200° FOV · UWF retinal mosaic
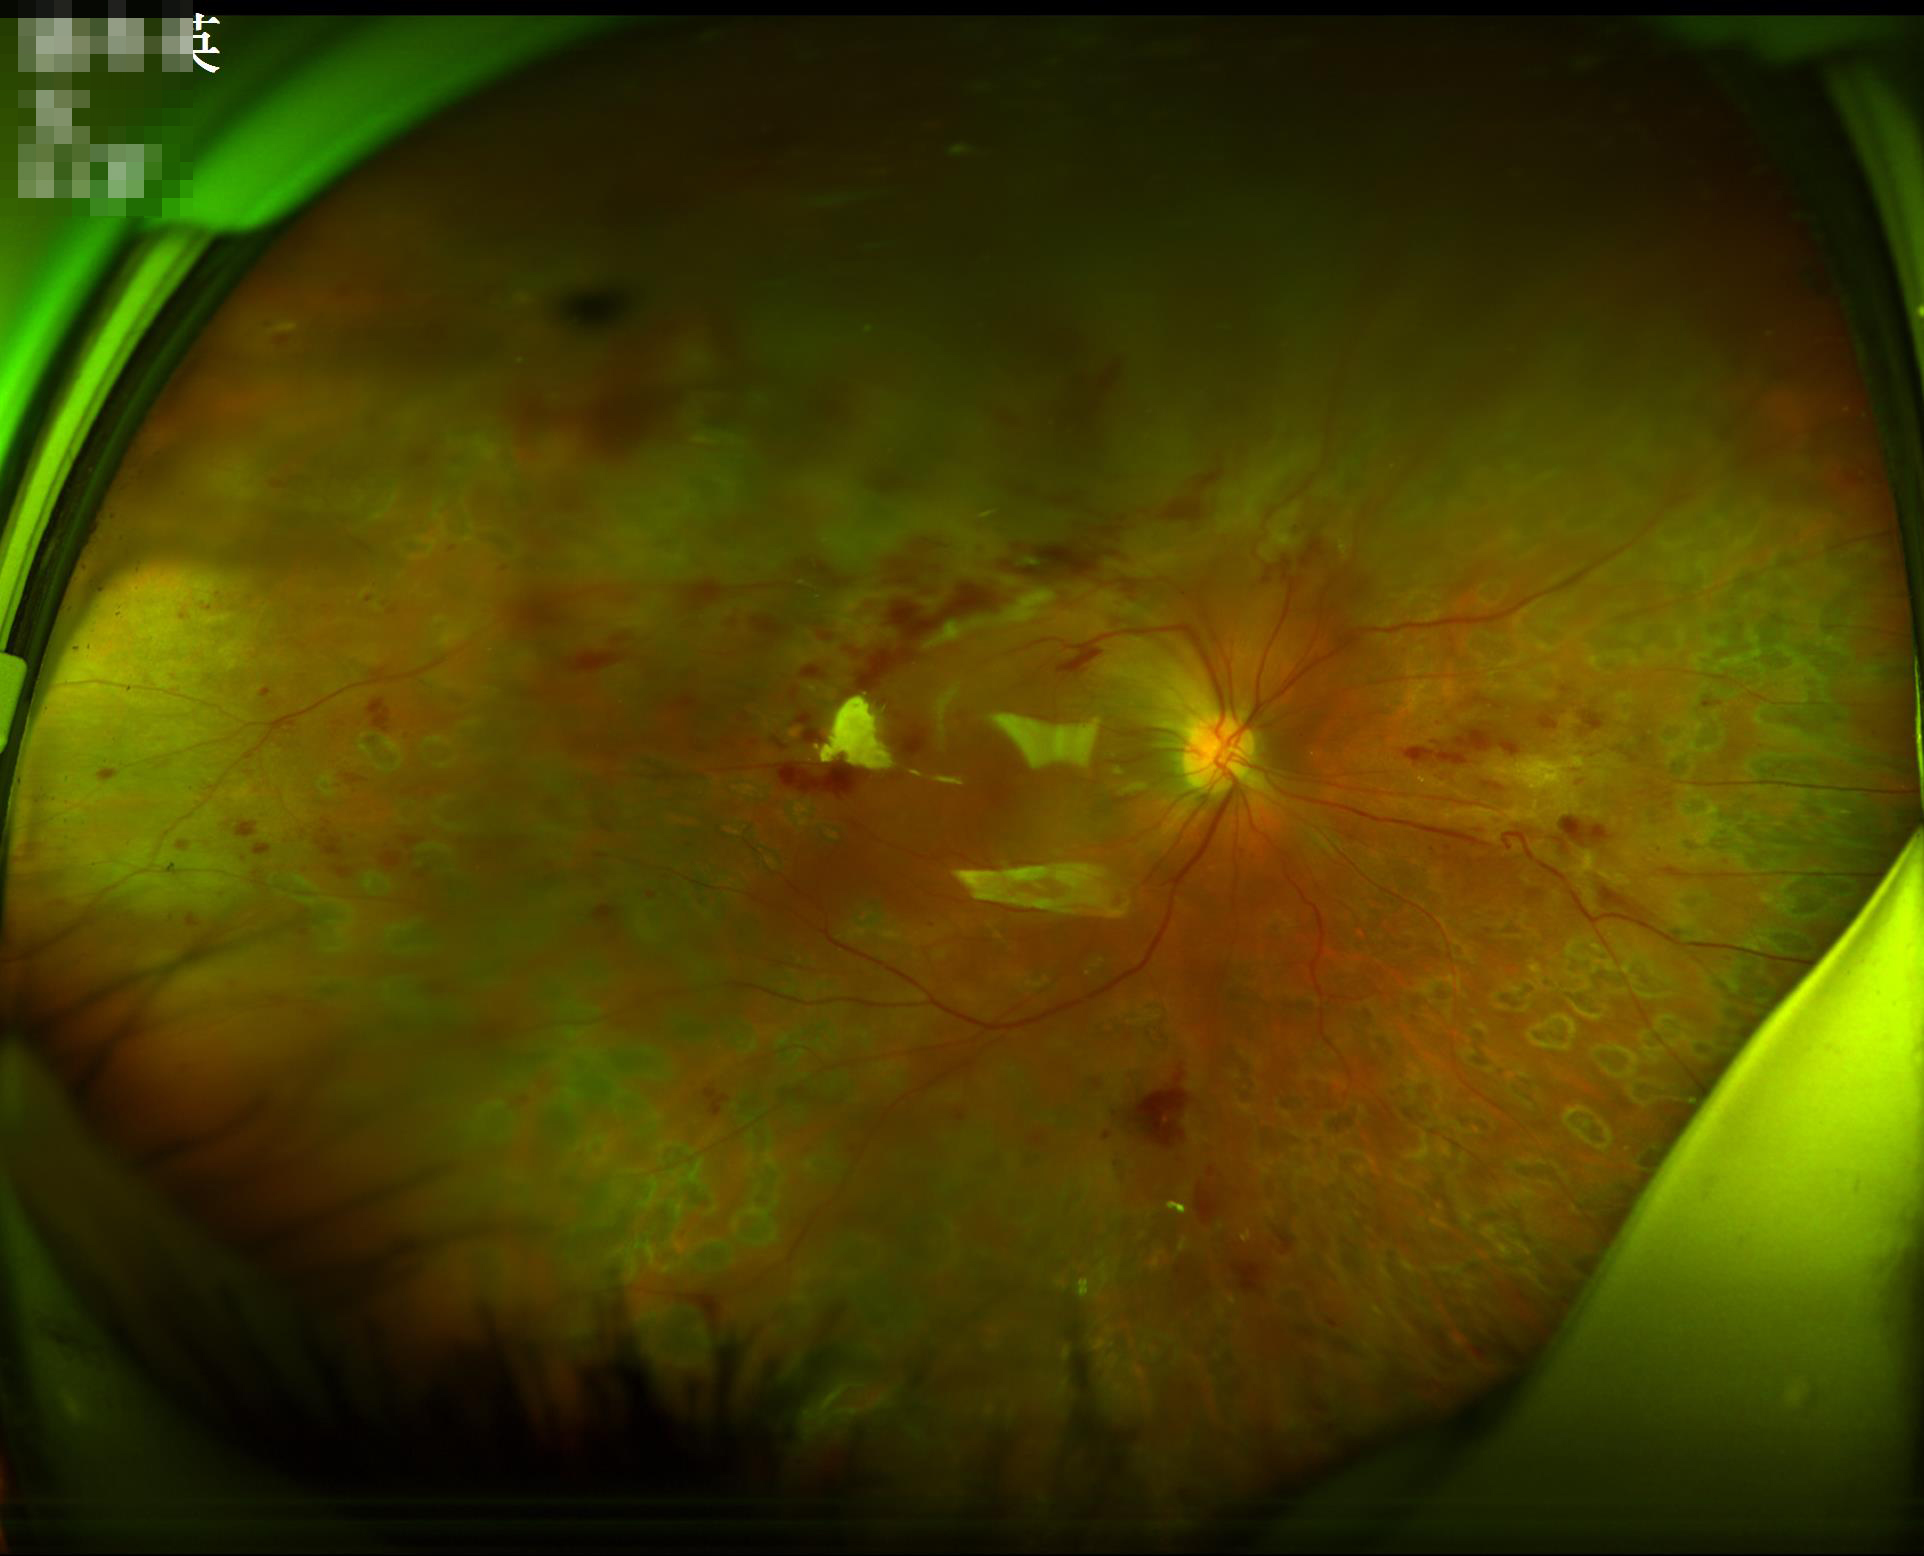

Image quality assessment: illumination/color: suboptimal; overall: poor; focus: poor.